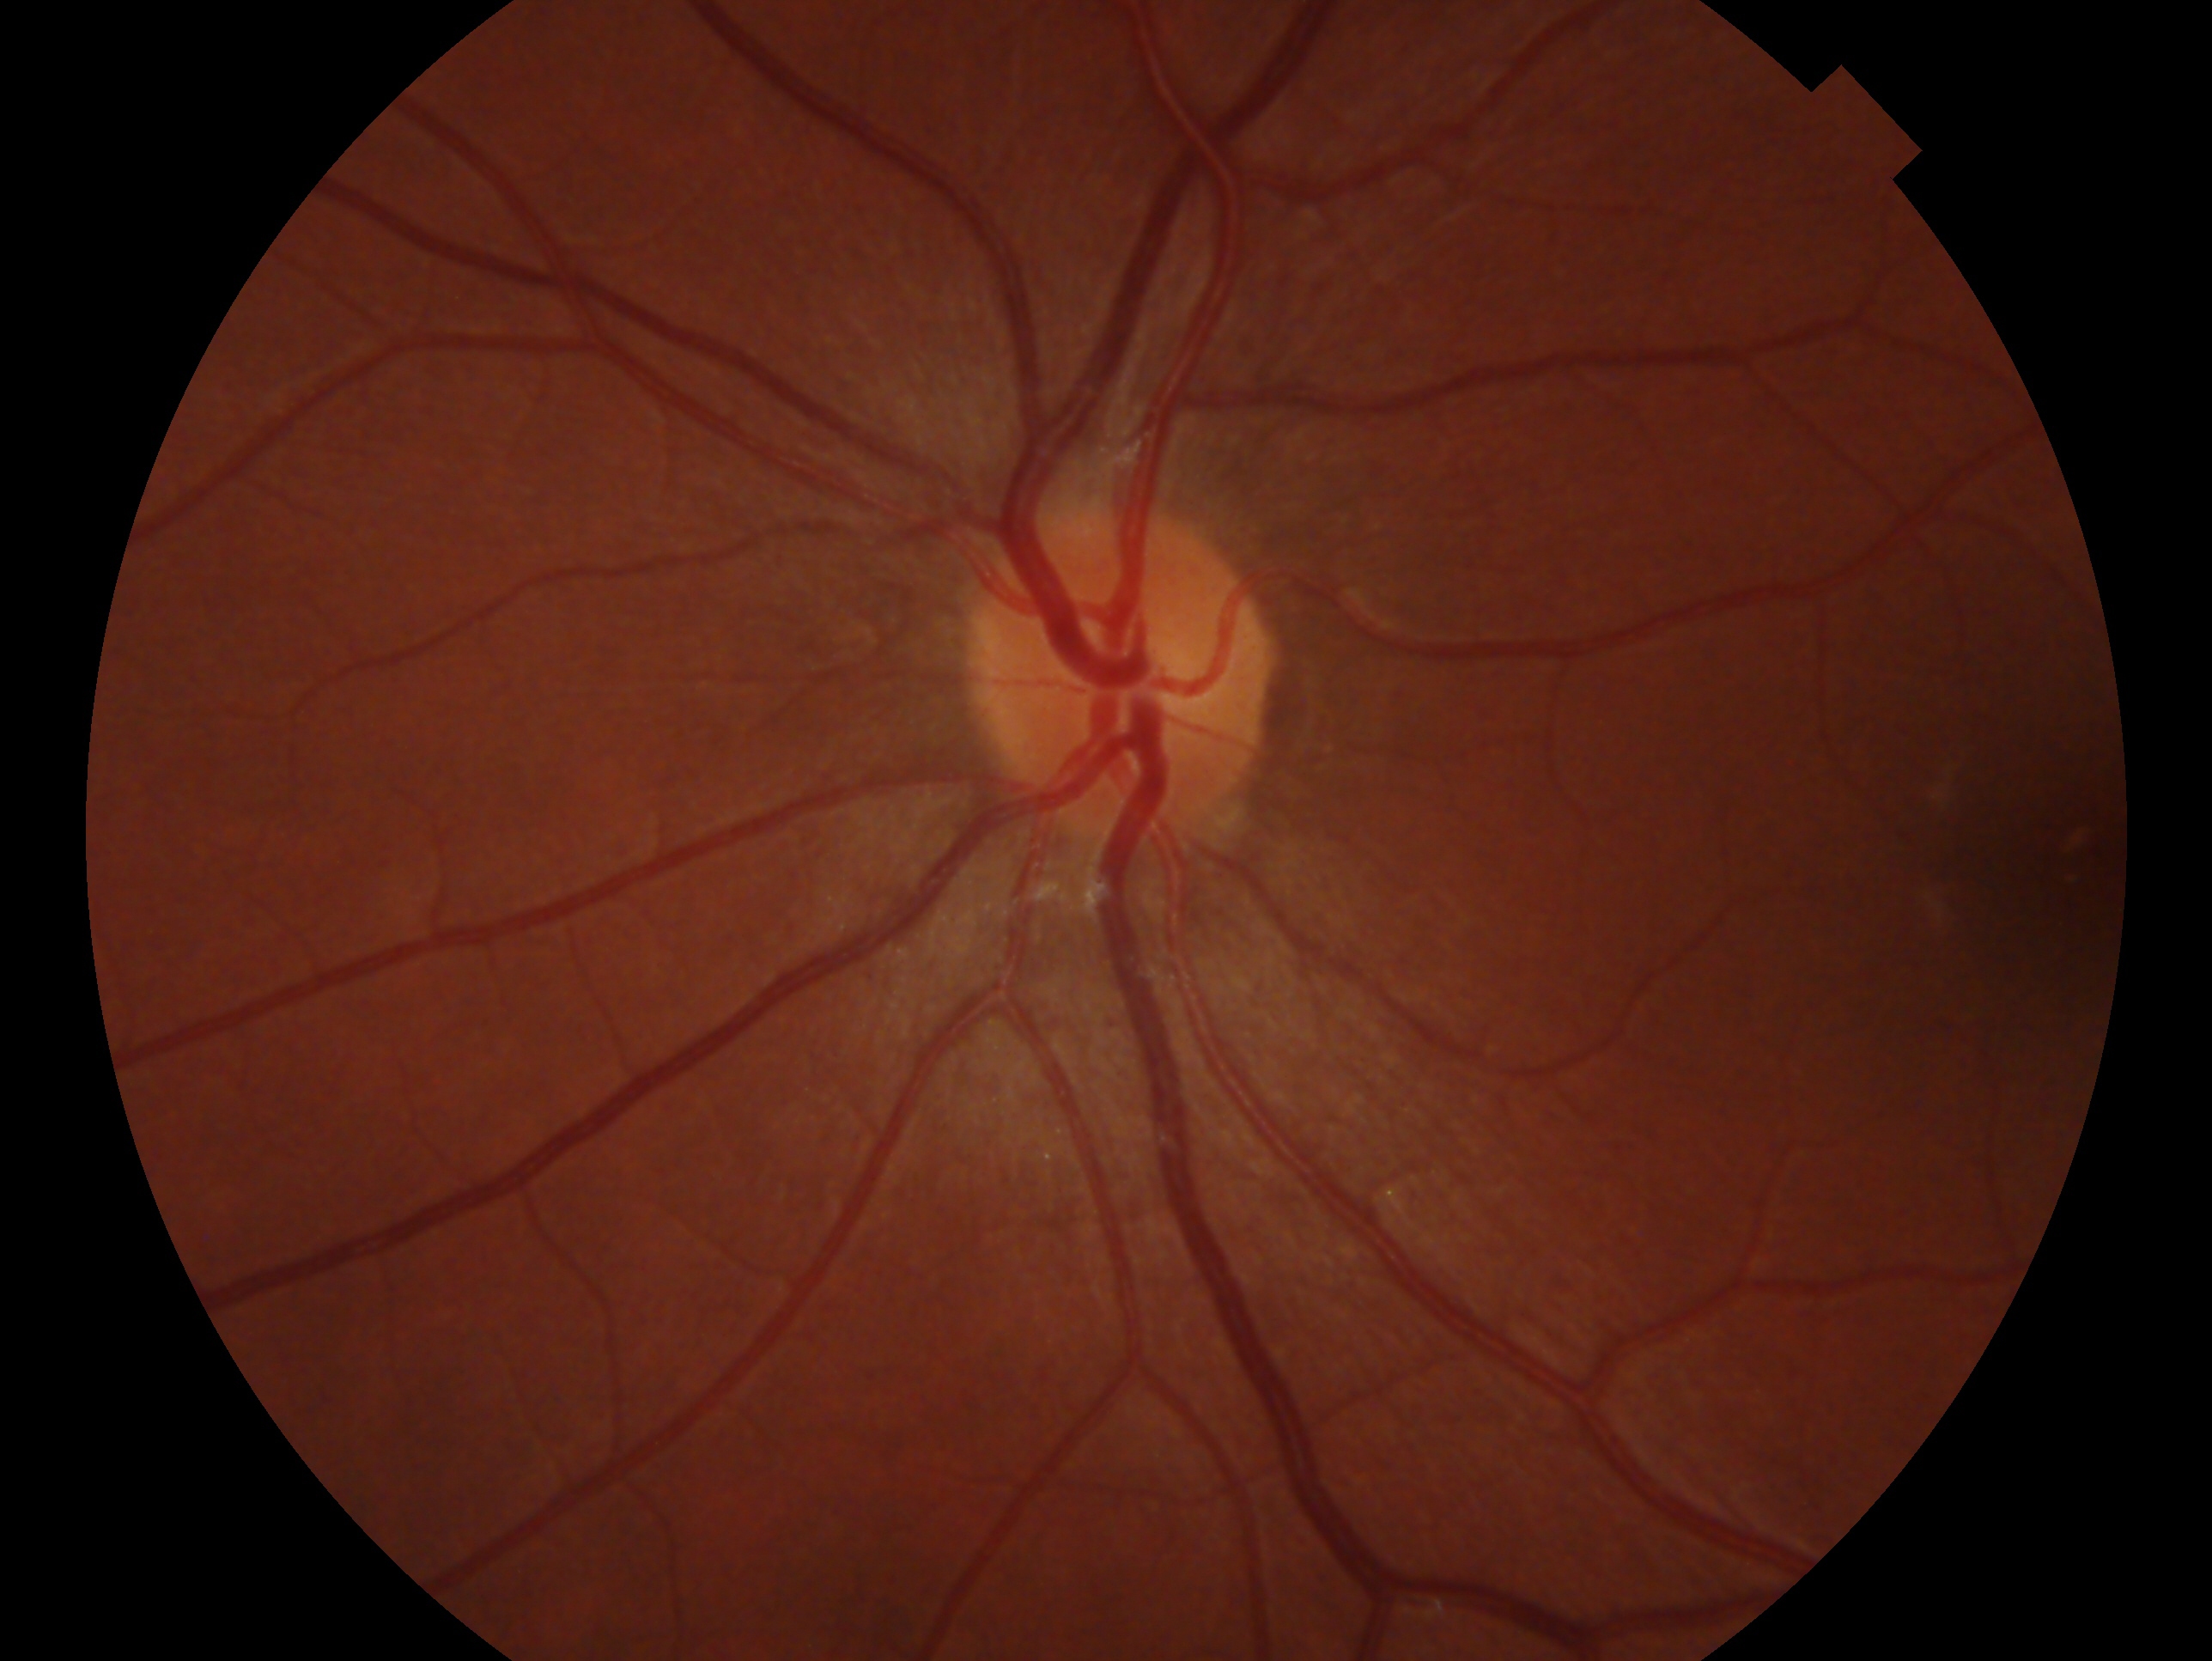
Glaucoma assessment: no evidence of glaucoma.
This is the left eye.